Wide-field fundus photograph from neonatal ROP screening: 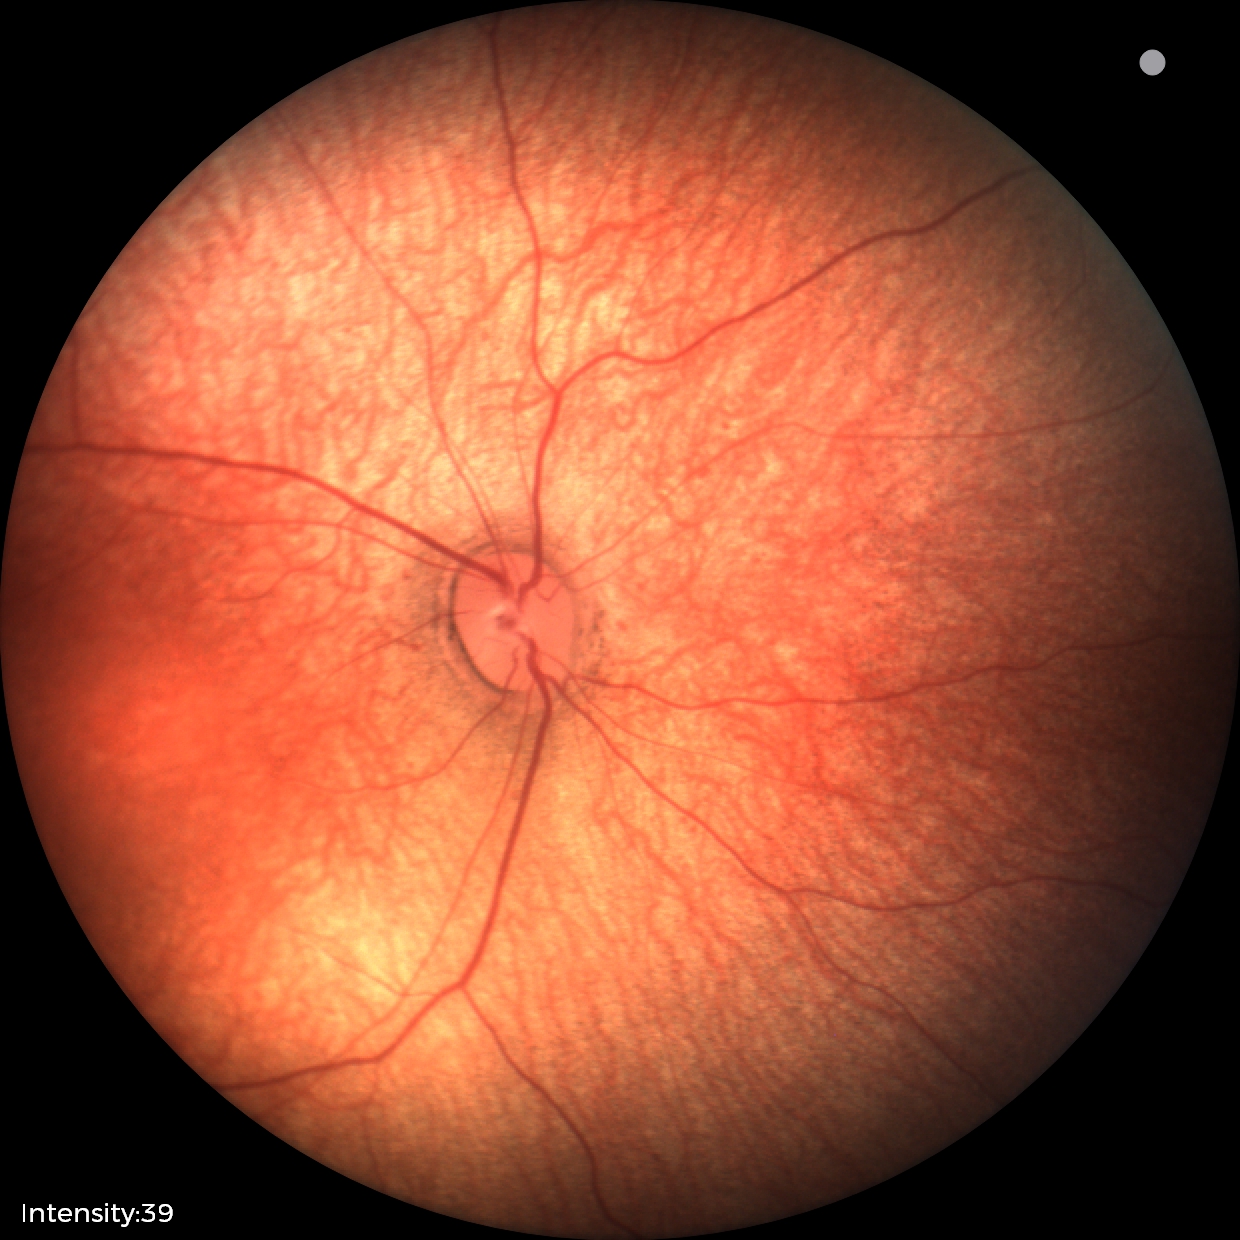

Screening: no abnormal retinal findings.